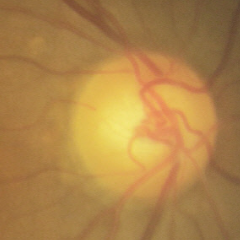 Glaucoma stage = no glaucoma.